Retinal fundus photograph. 45° field of view: 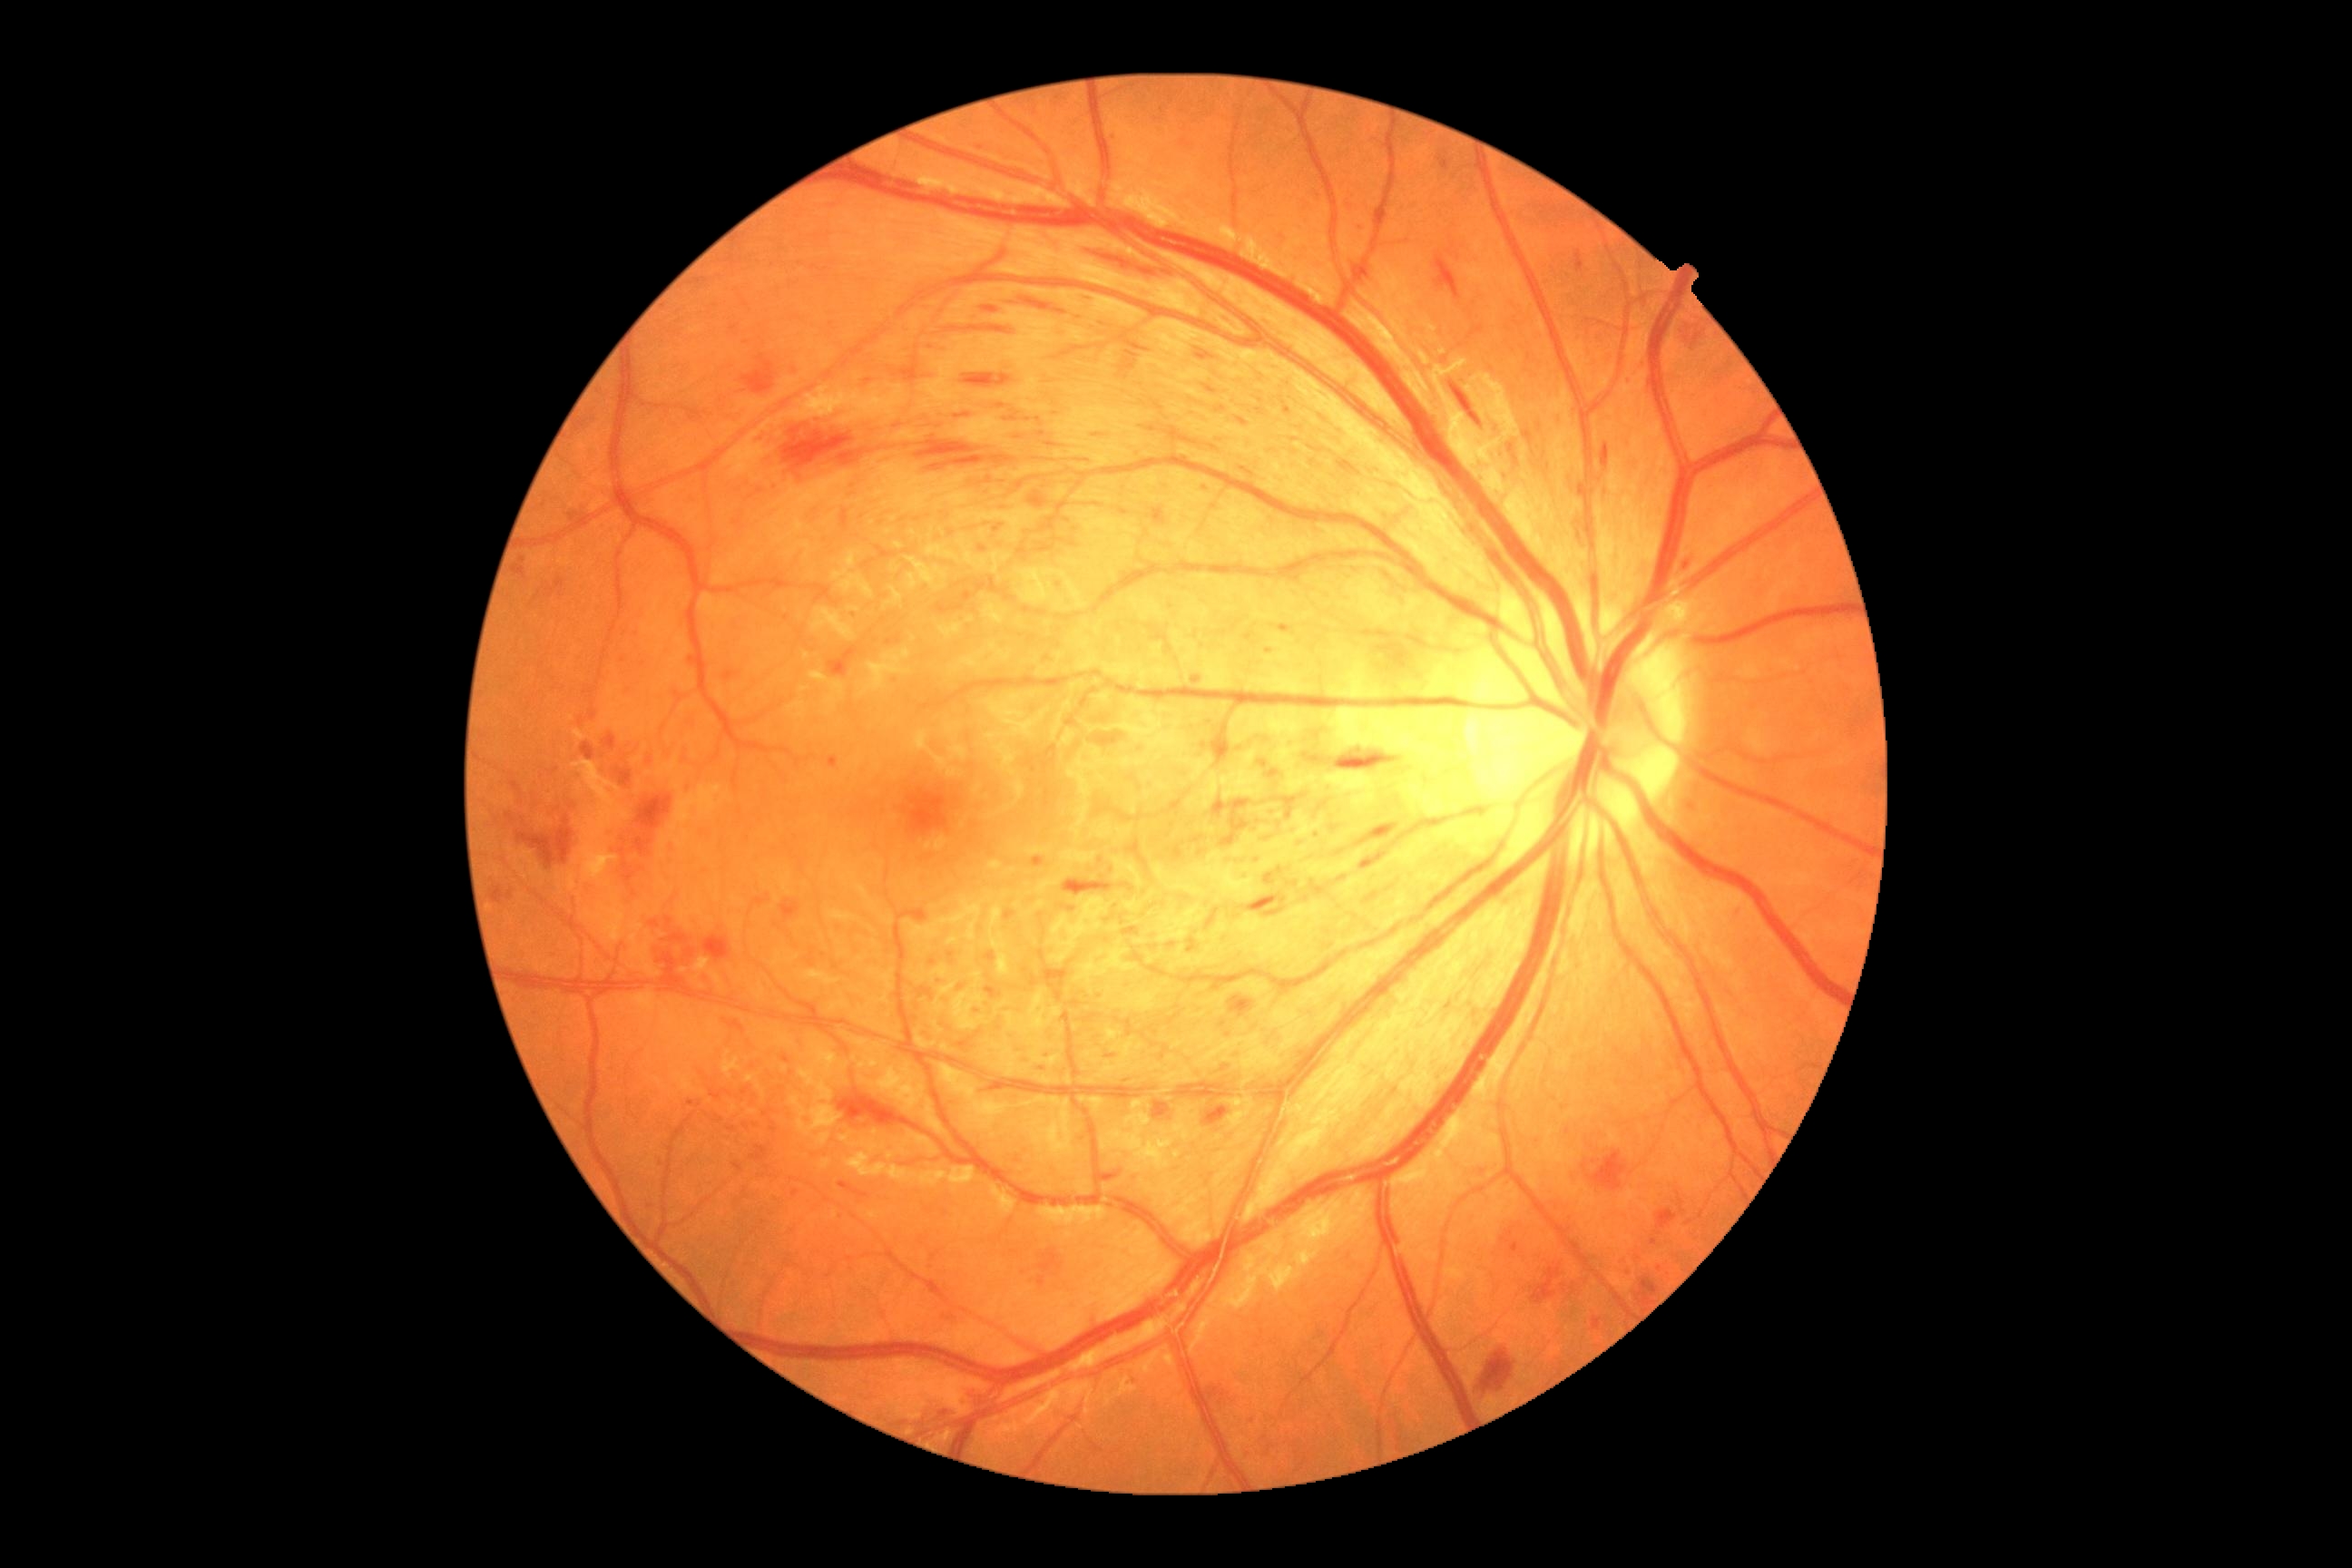
Retinopathy is grade 3 (severe NPDR).